Color fundus image; 2352 by 1568 pixels; FOV: 45 degrees — 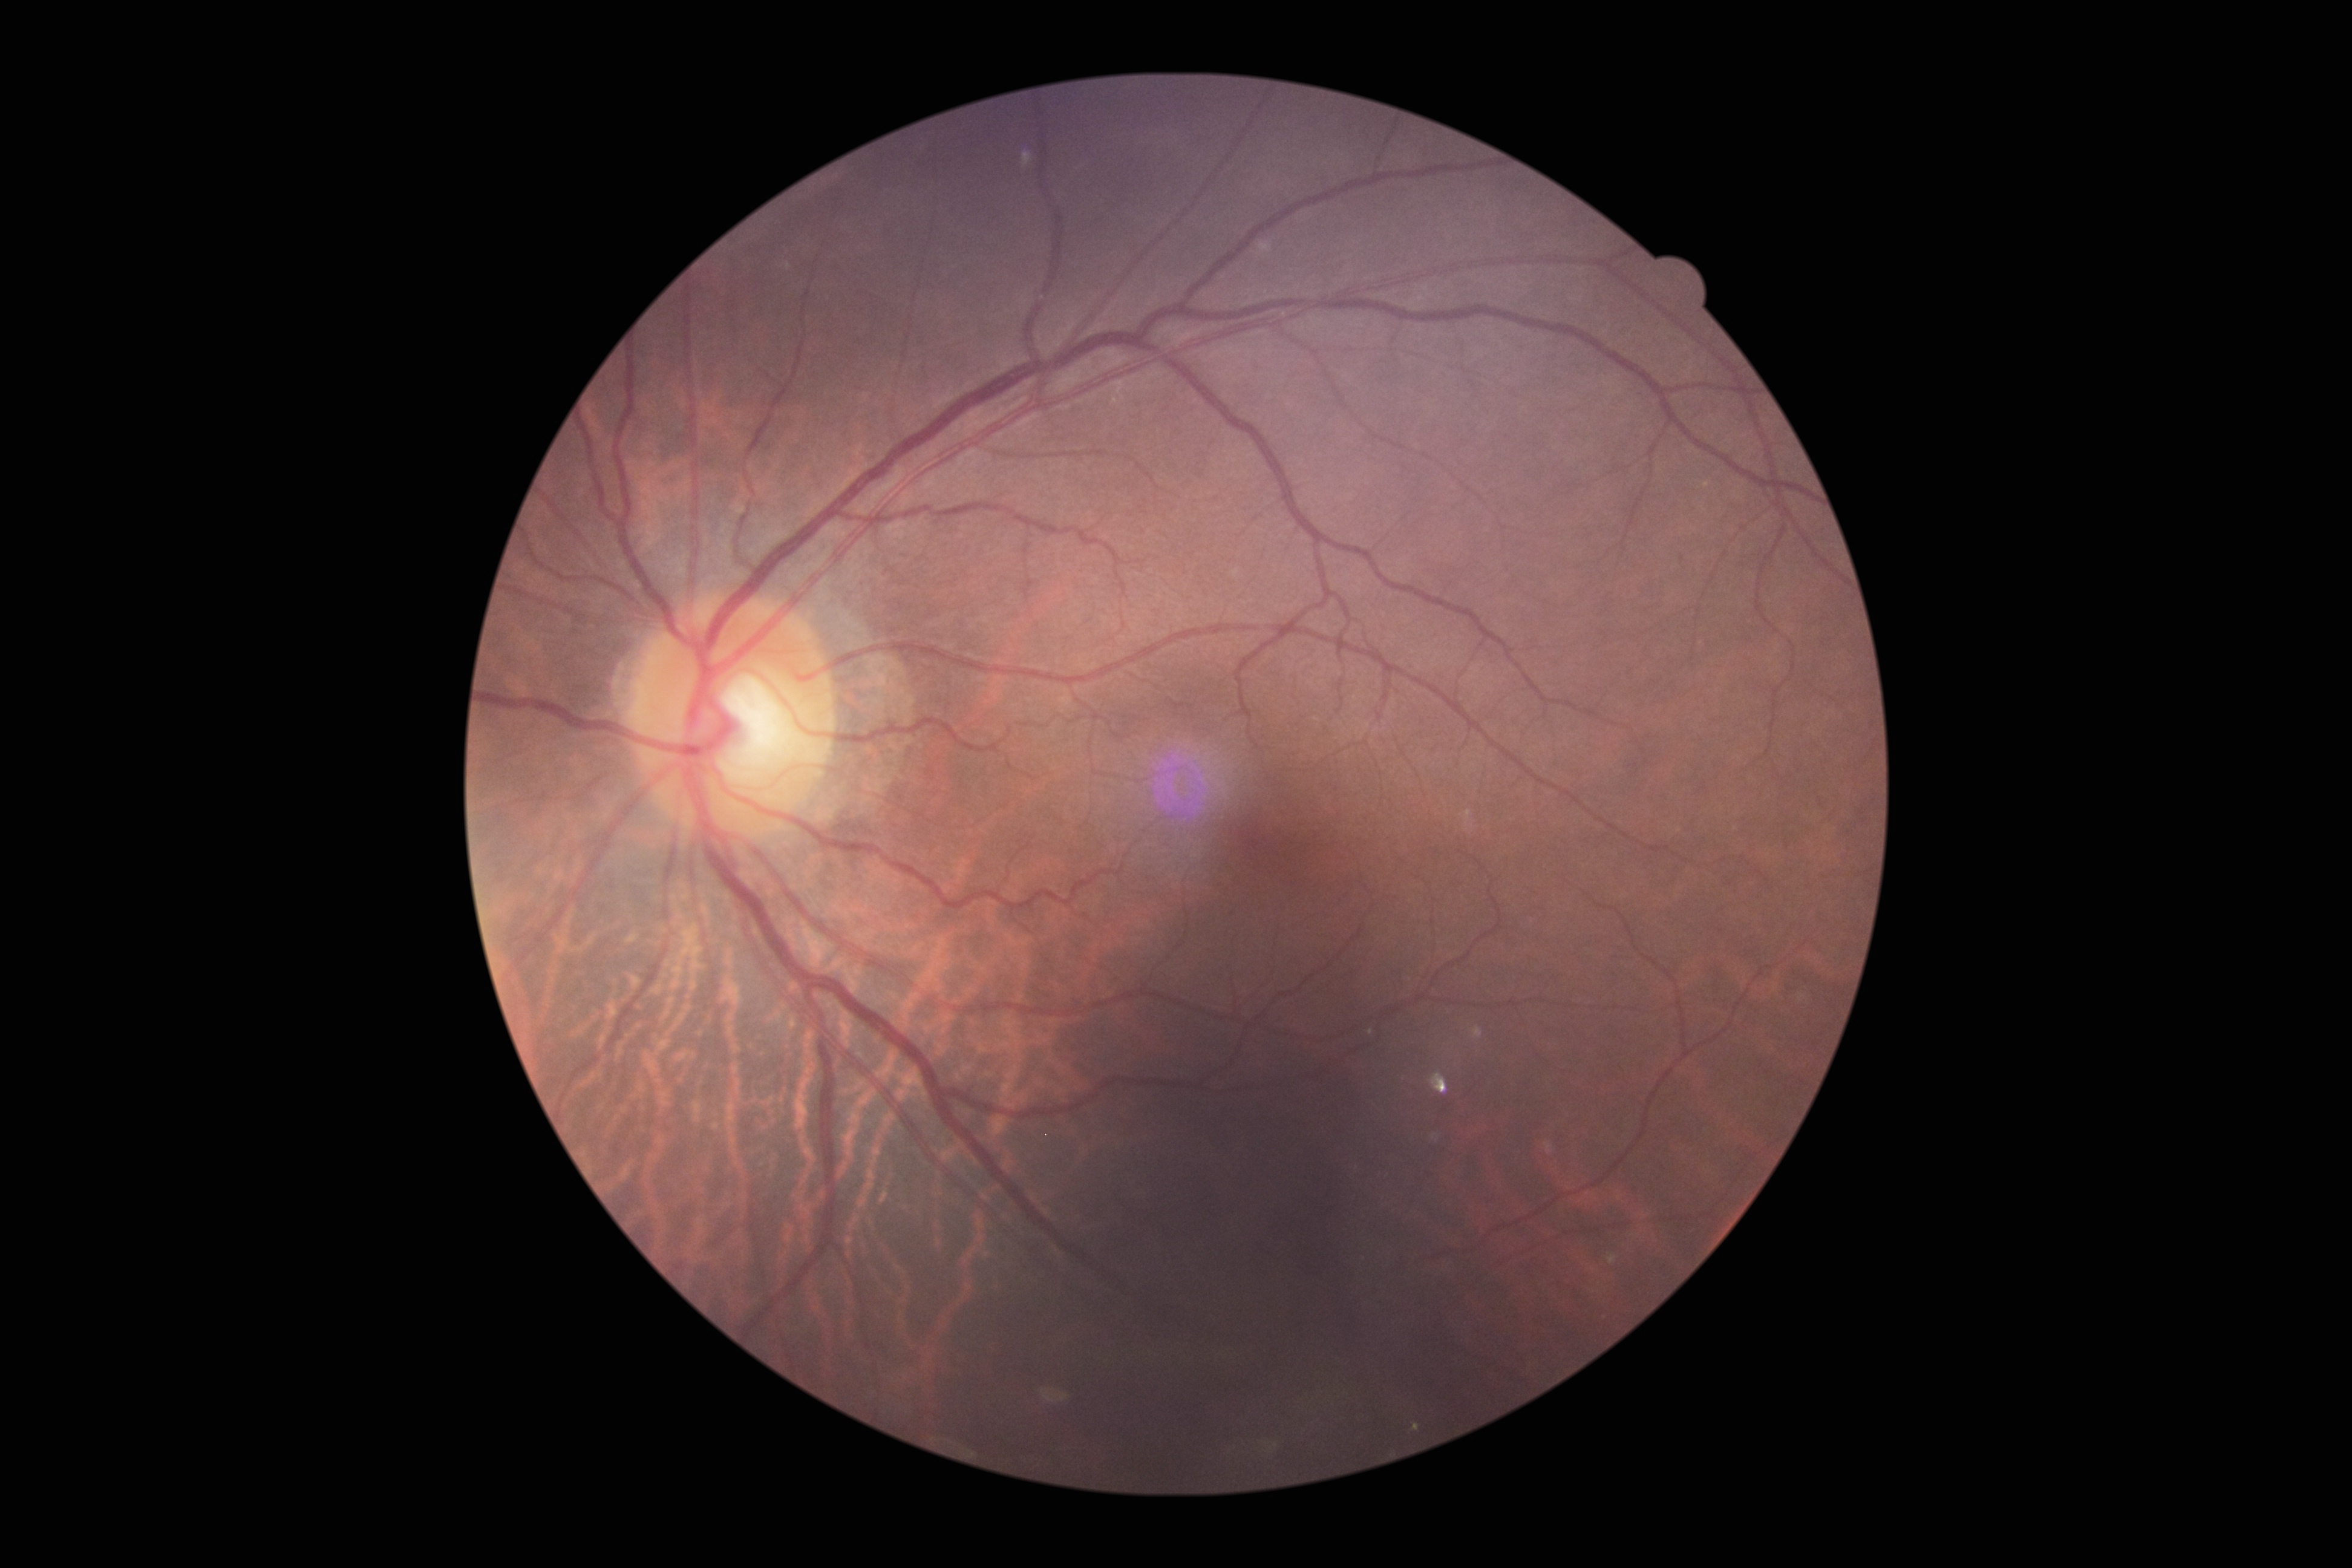 Diabetic retinopathy (DR) is grade 0 (no apparent retinopathy).
No apparent diabetic retinopathy.